Modified Davis grading
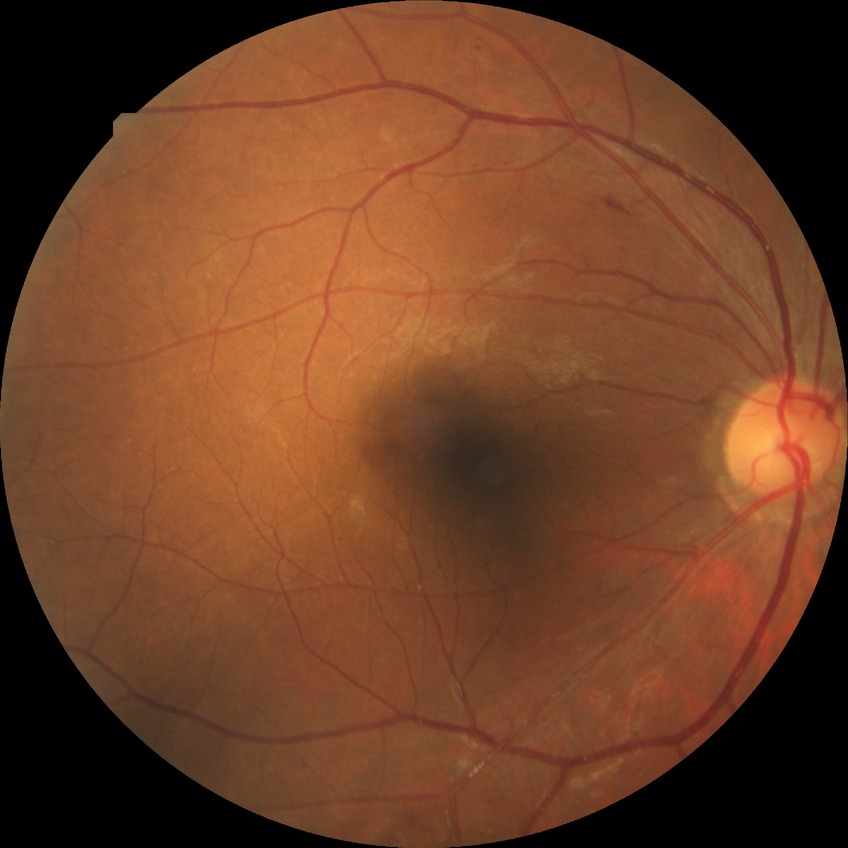 Diabetic retinopathy severity is simple diabetic retinopathy.